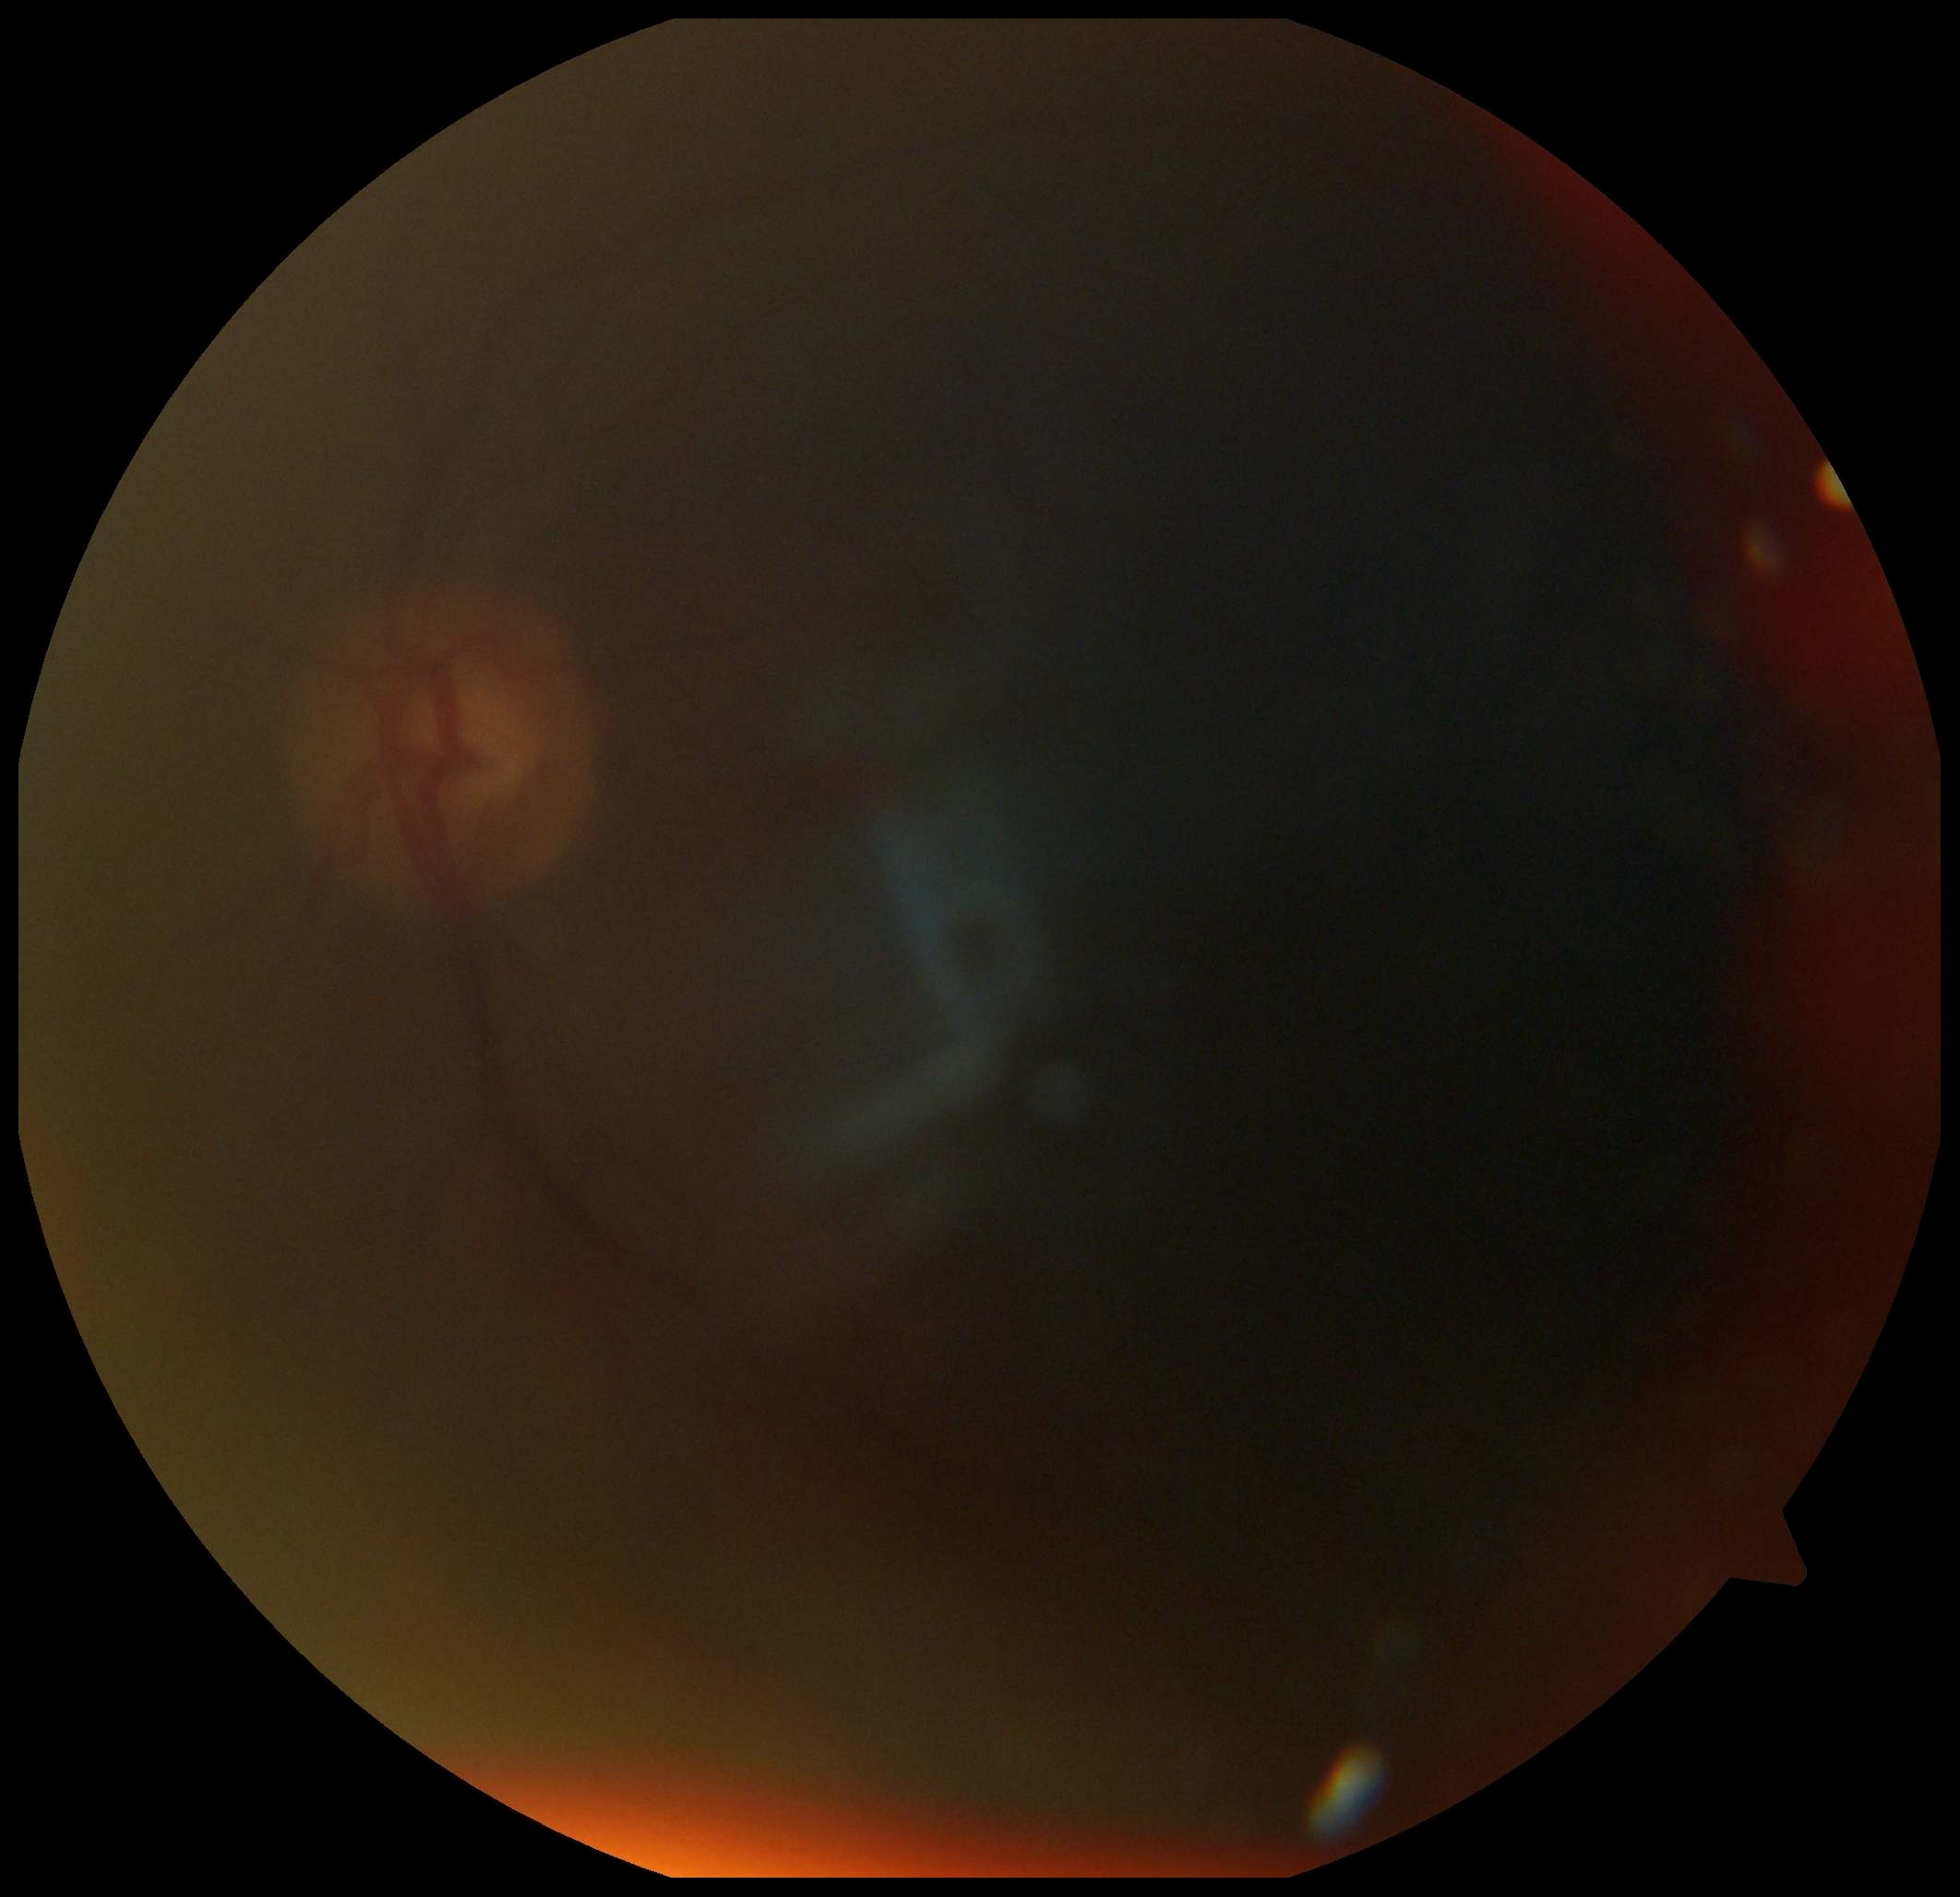 * image quality: insufficient for DR assessment
* DR: ungradable